45° FOV.
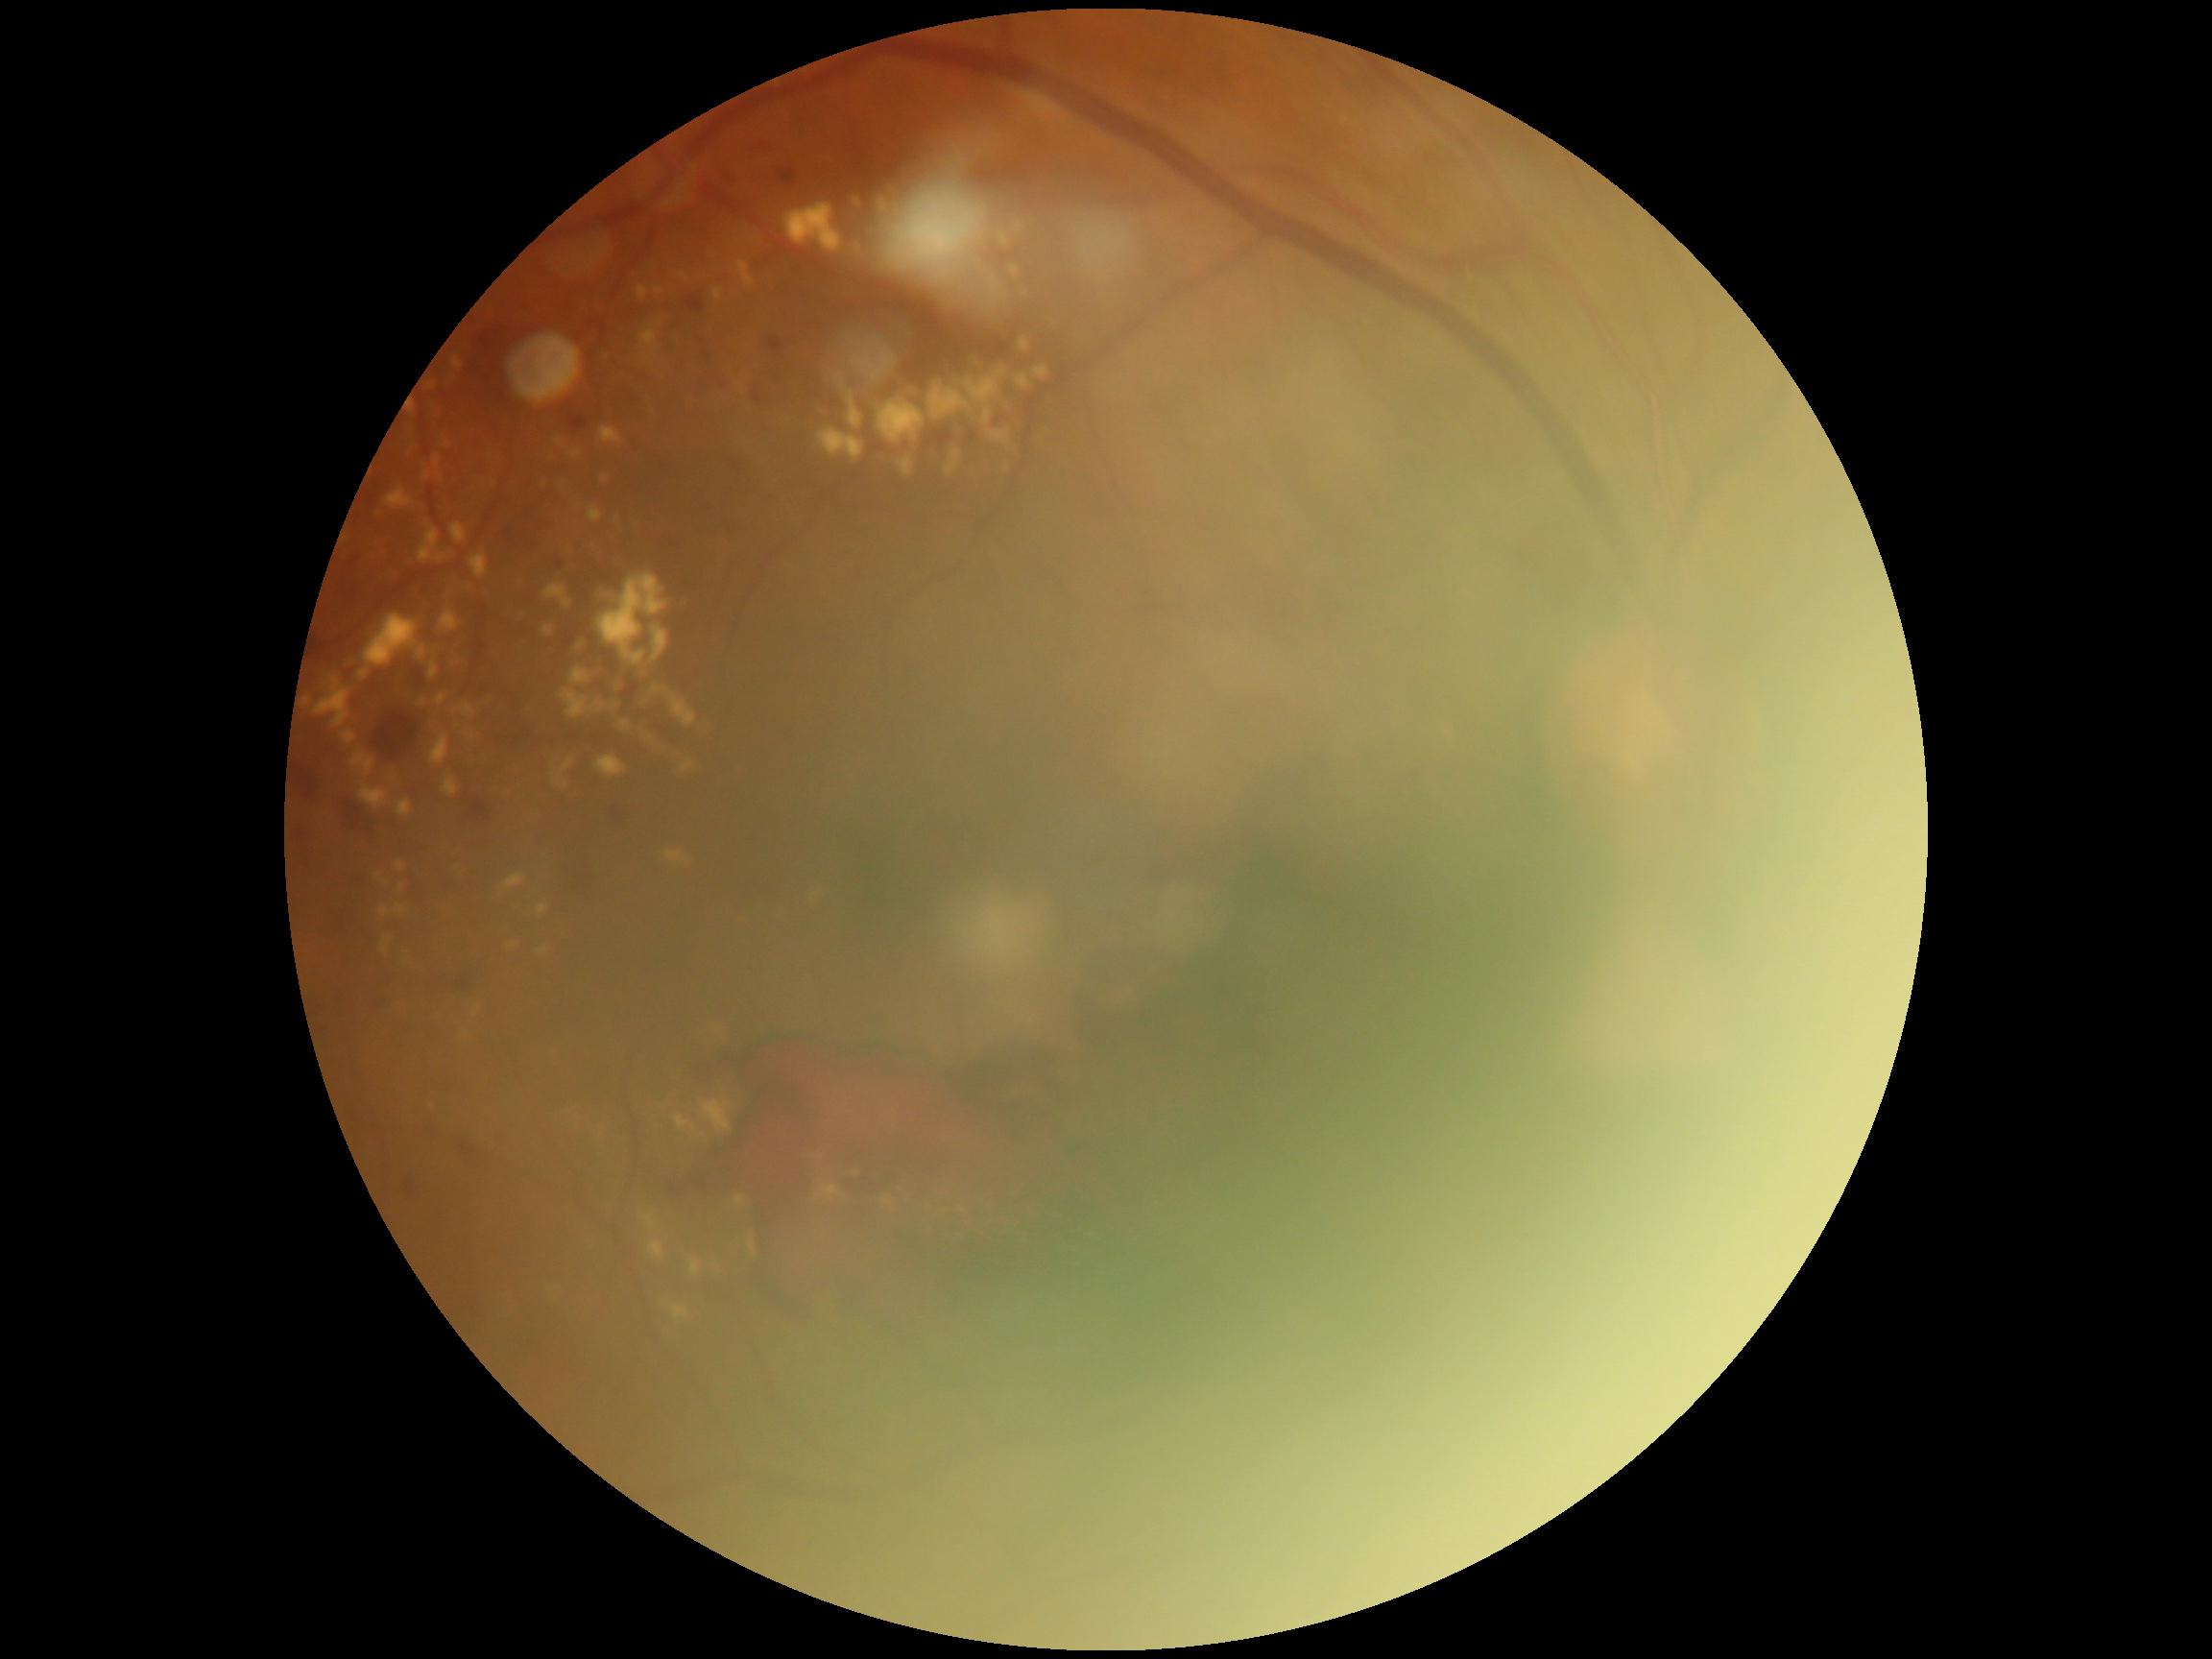
Retinopathy grade: 4.